848x848px; 45° FOV; posterior pole color fundus photograph; no pharmacologic dilation; NIDEK AFC-230; graded on the modified Davis scale:
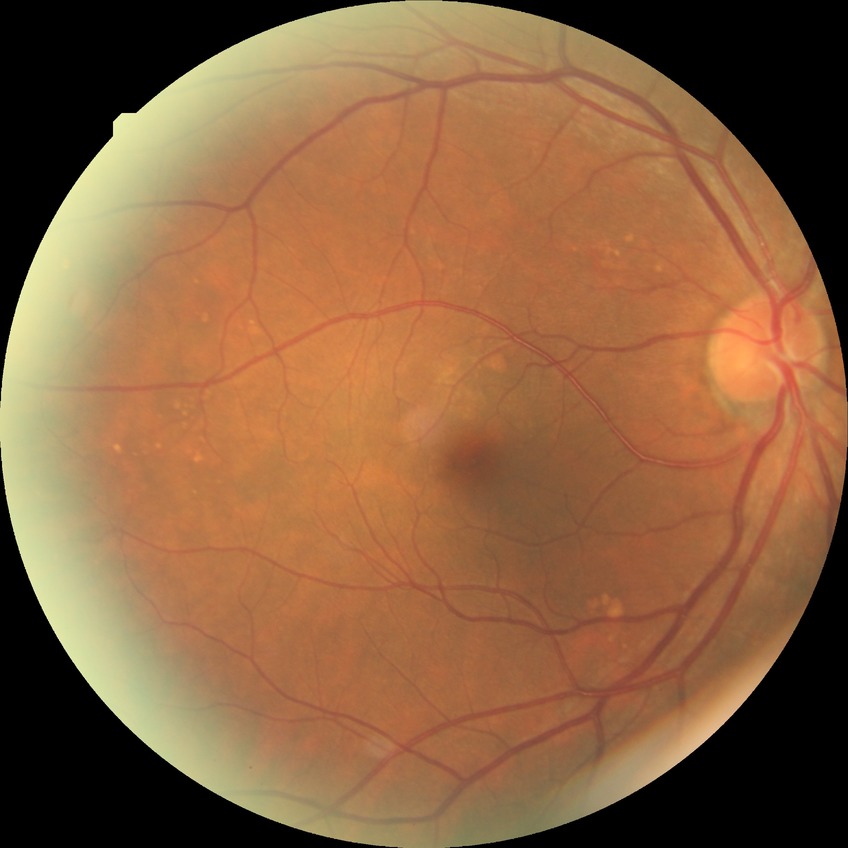
Assessment:
• Davis DR grade — NDR
• DR impression — no apparent DR